Retinal fundus photograph: 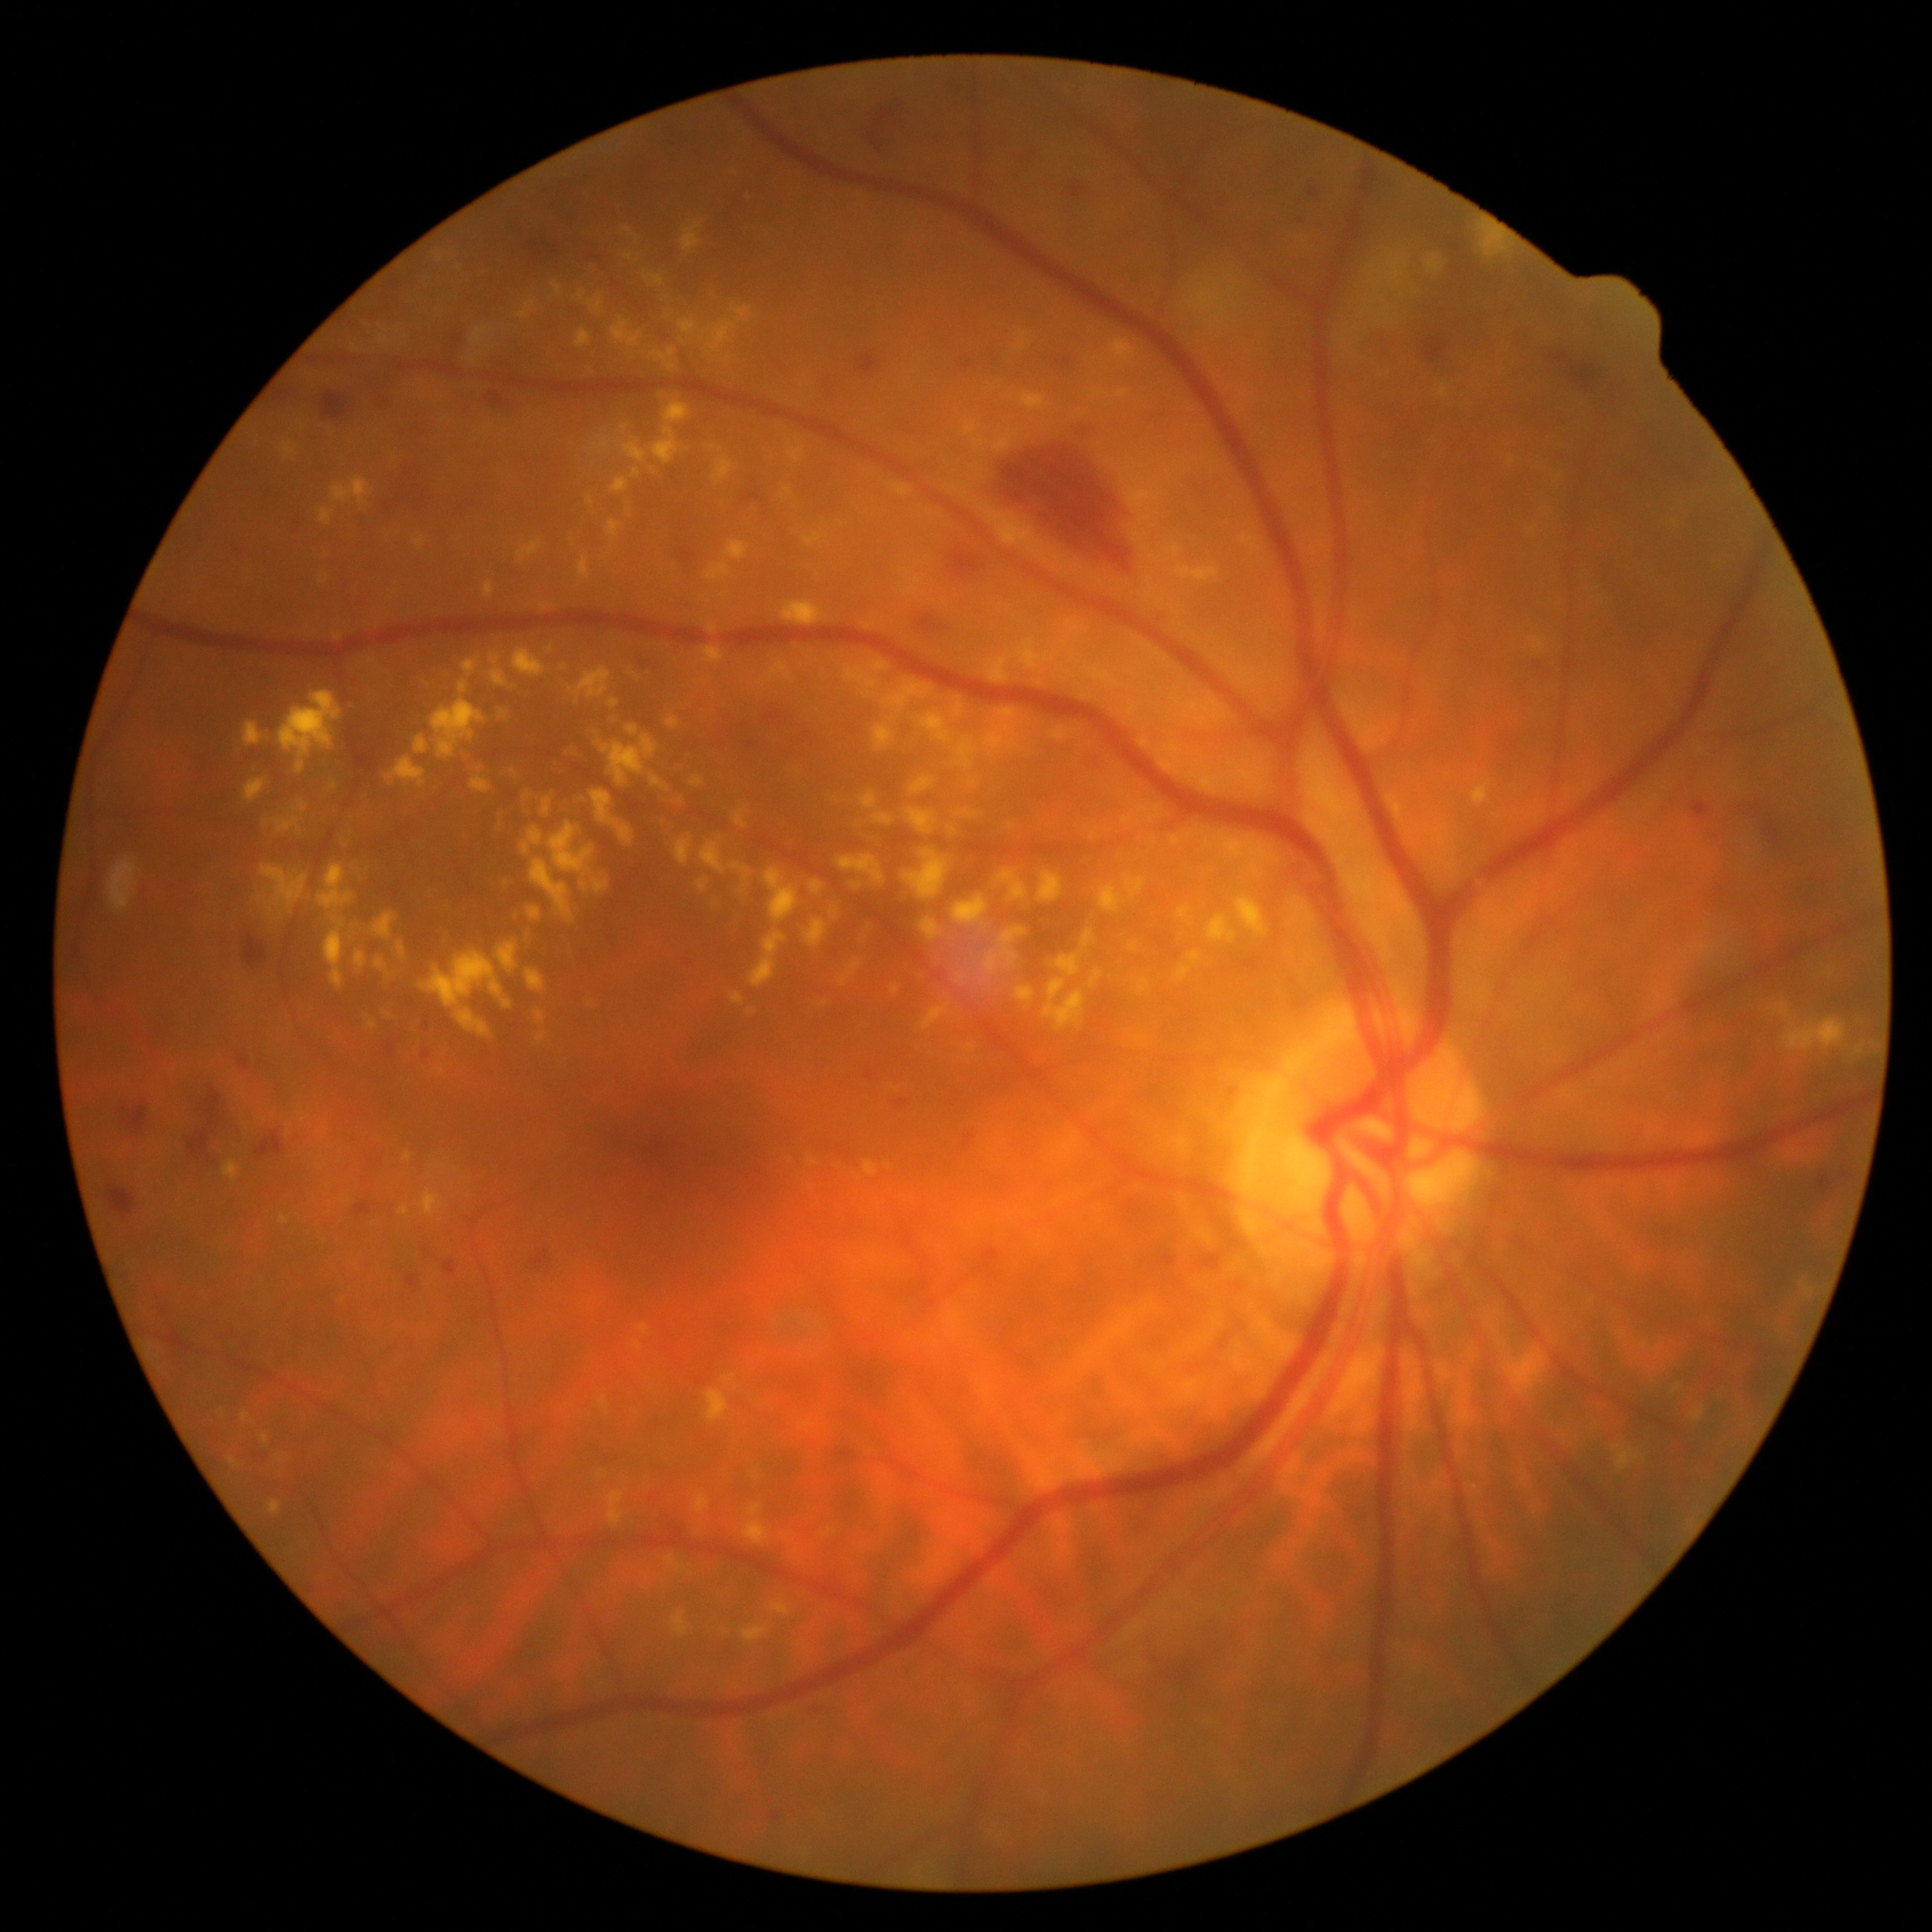

Retinopathy is moderate NPDR (grade 2) — more than just microaneurysms but less than severe NPDR.